Portable fundus photograph.
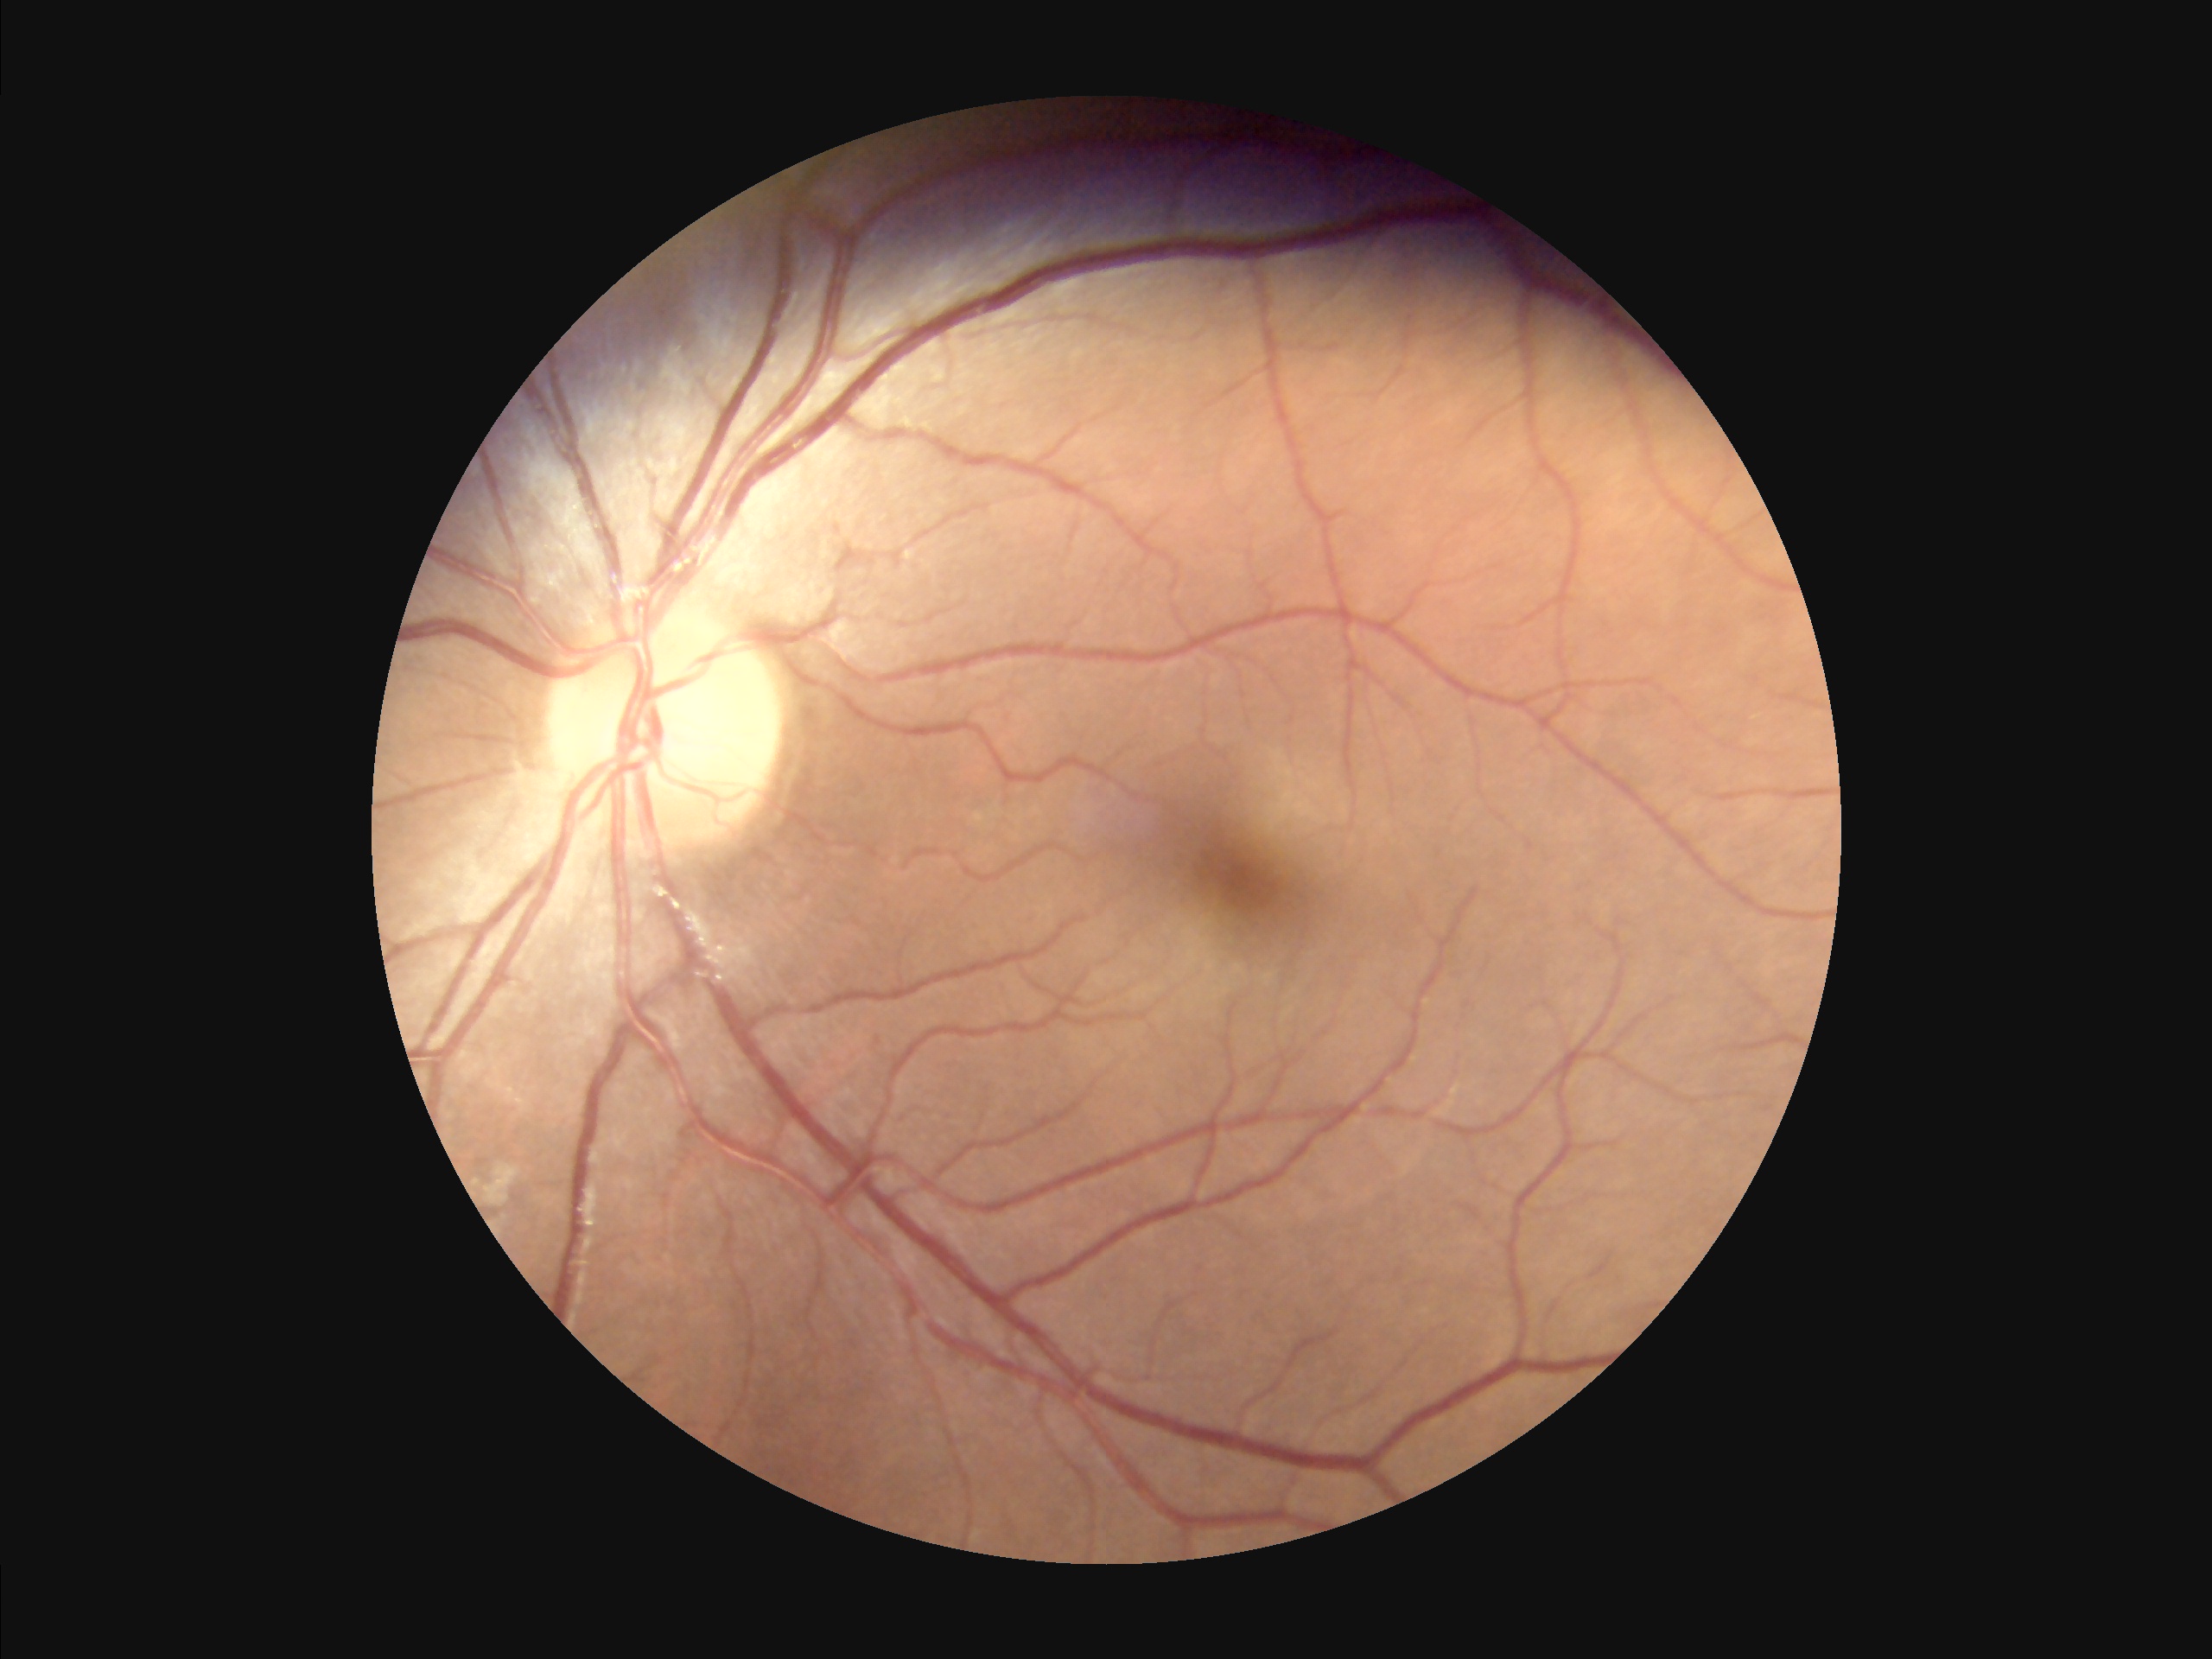

Image quality: focus: clear; contrast: satisfactory; overall: adequate.